RetCam wide-field infant fundus image
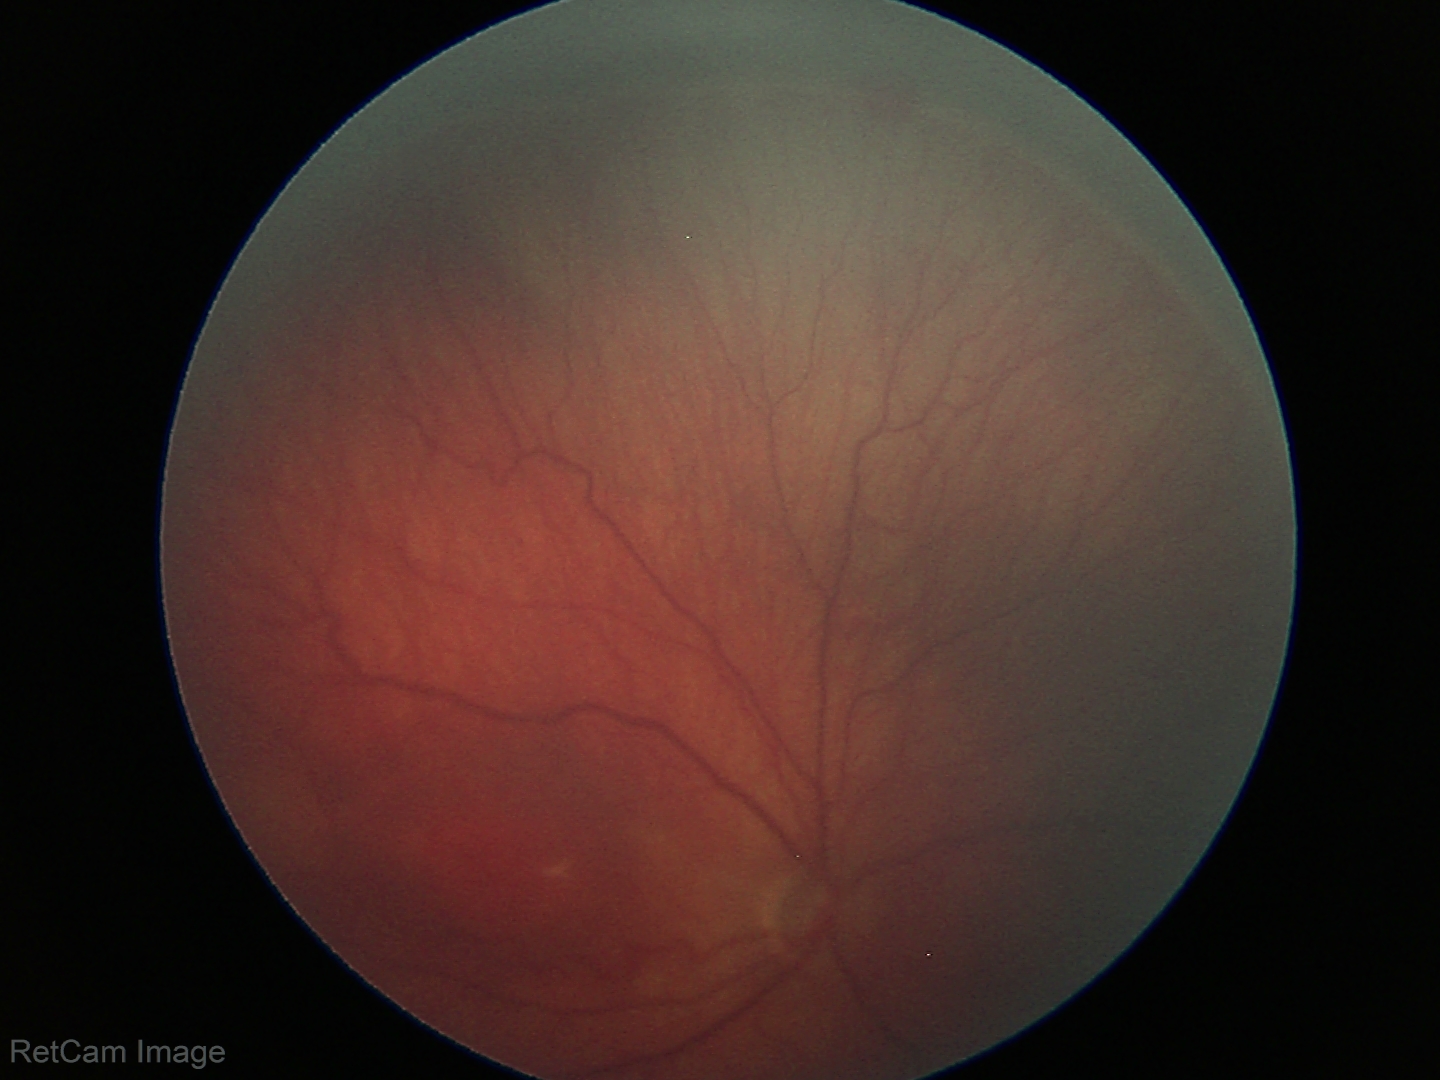

Assessment: retinopathy of prematurity stage 3.